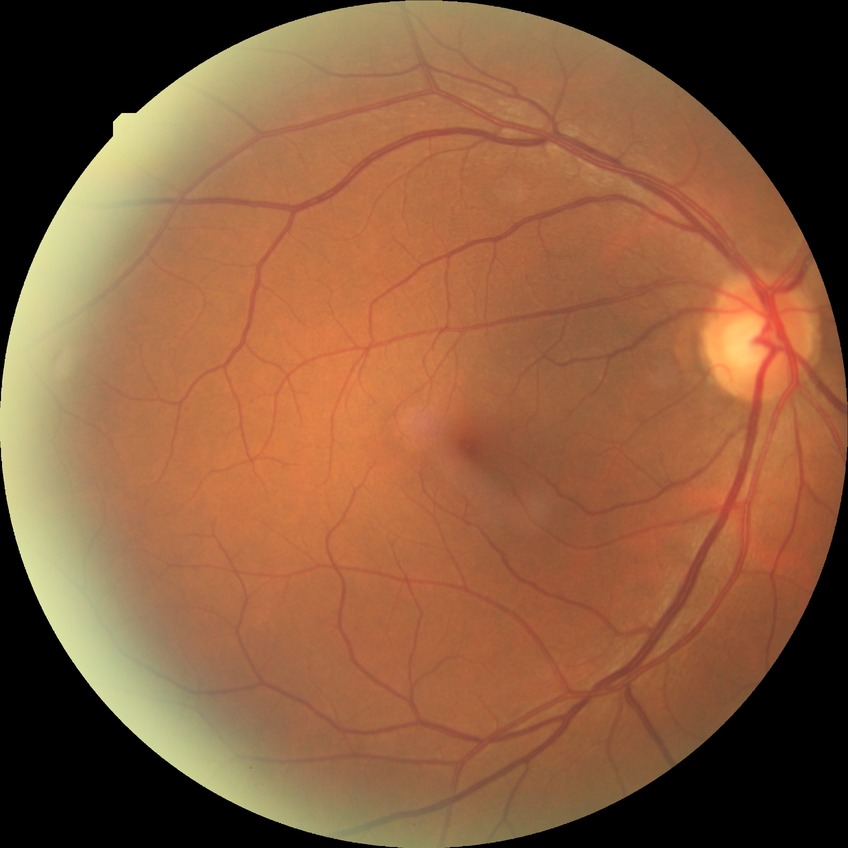 diabetic retinopathy (DR)@no diabetic retinopathy (NDR).